Retinal fundus photograph, FOV: 45 degrees
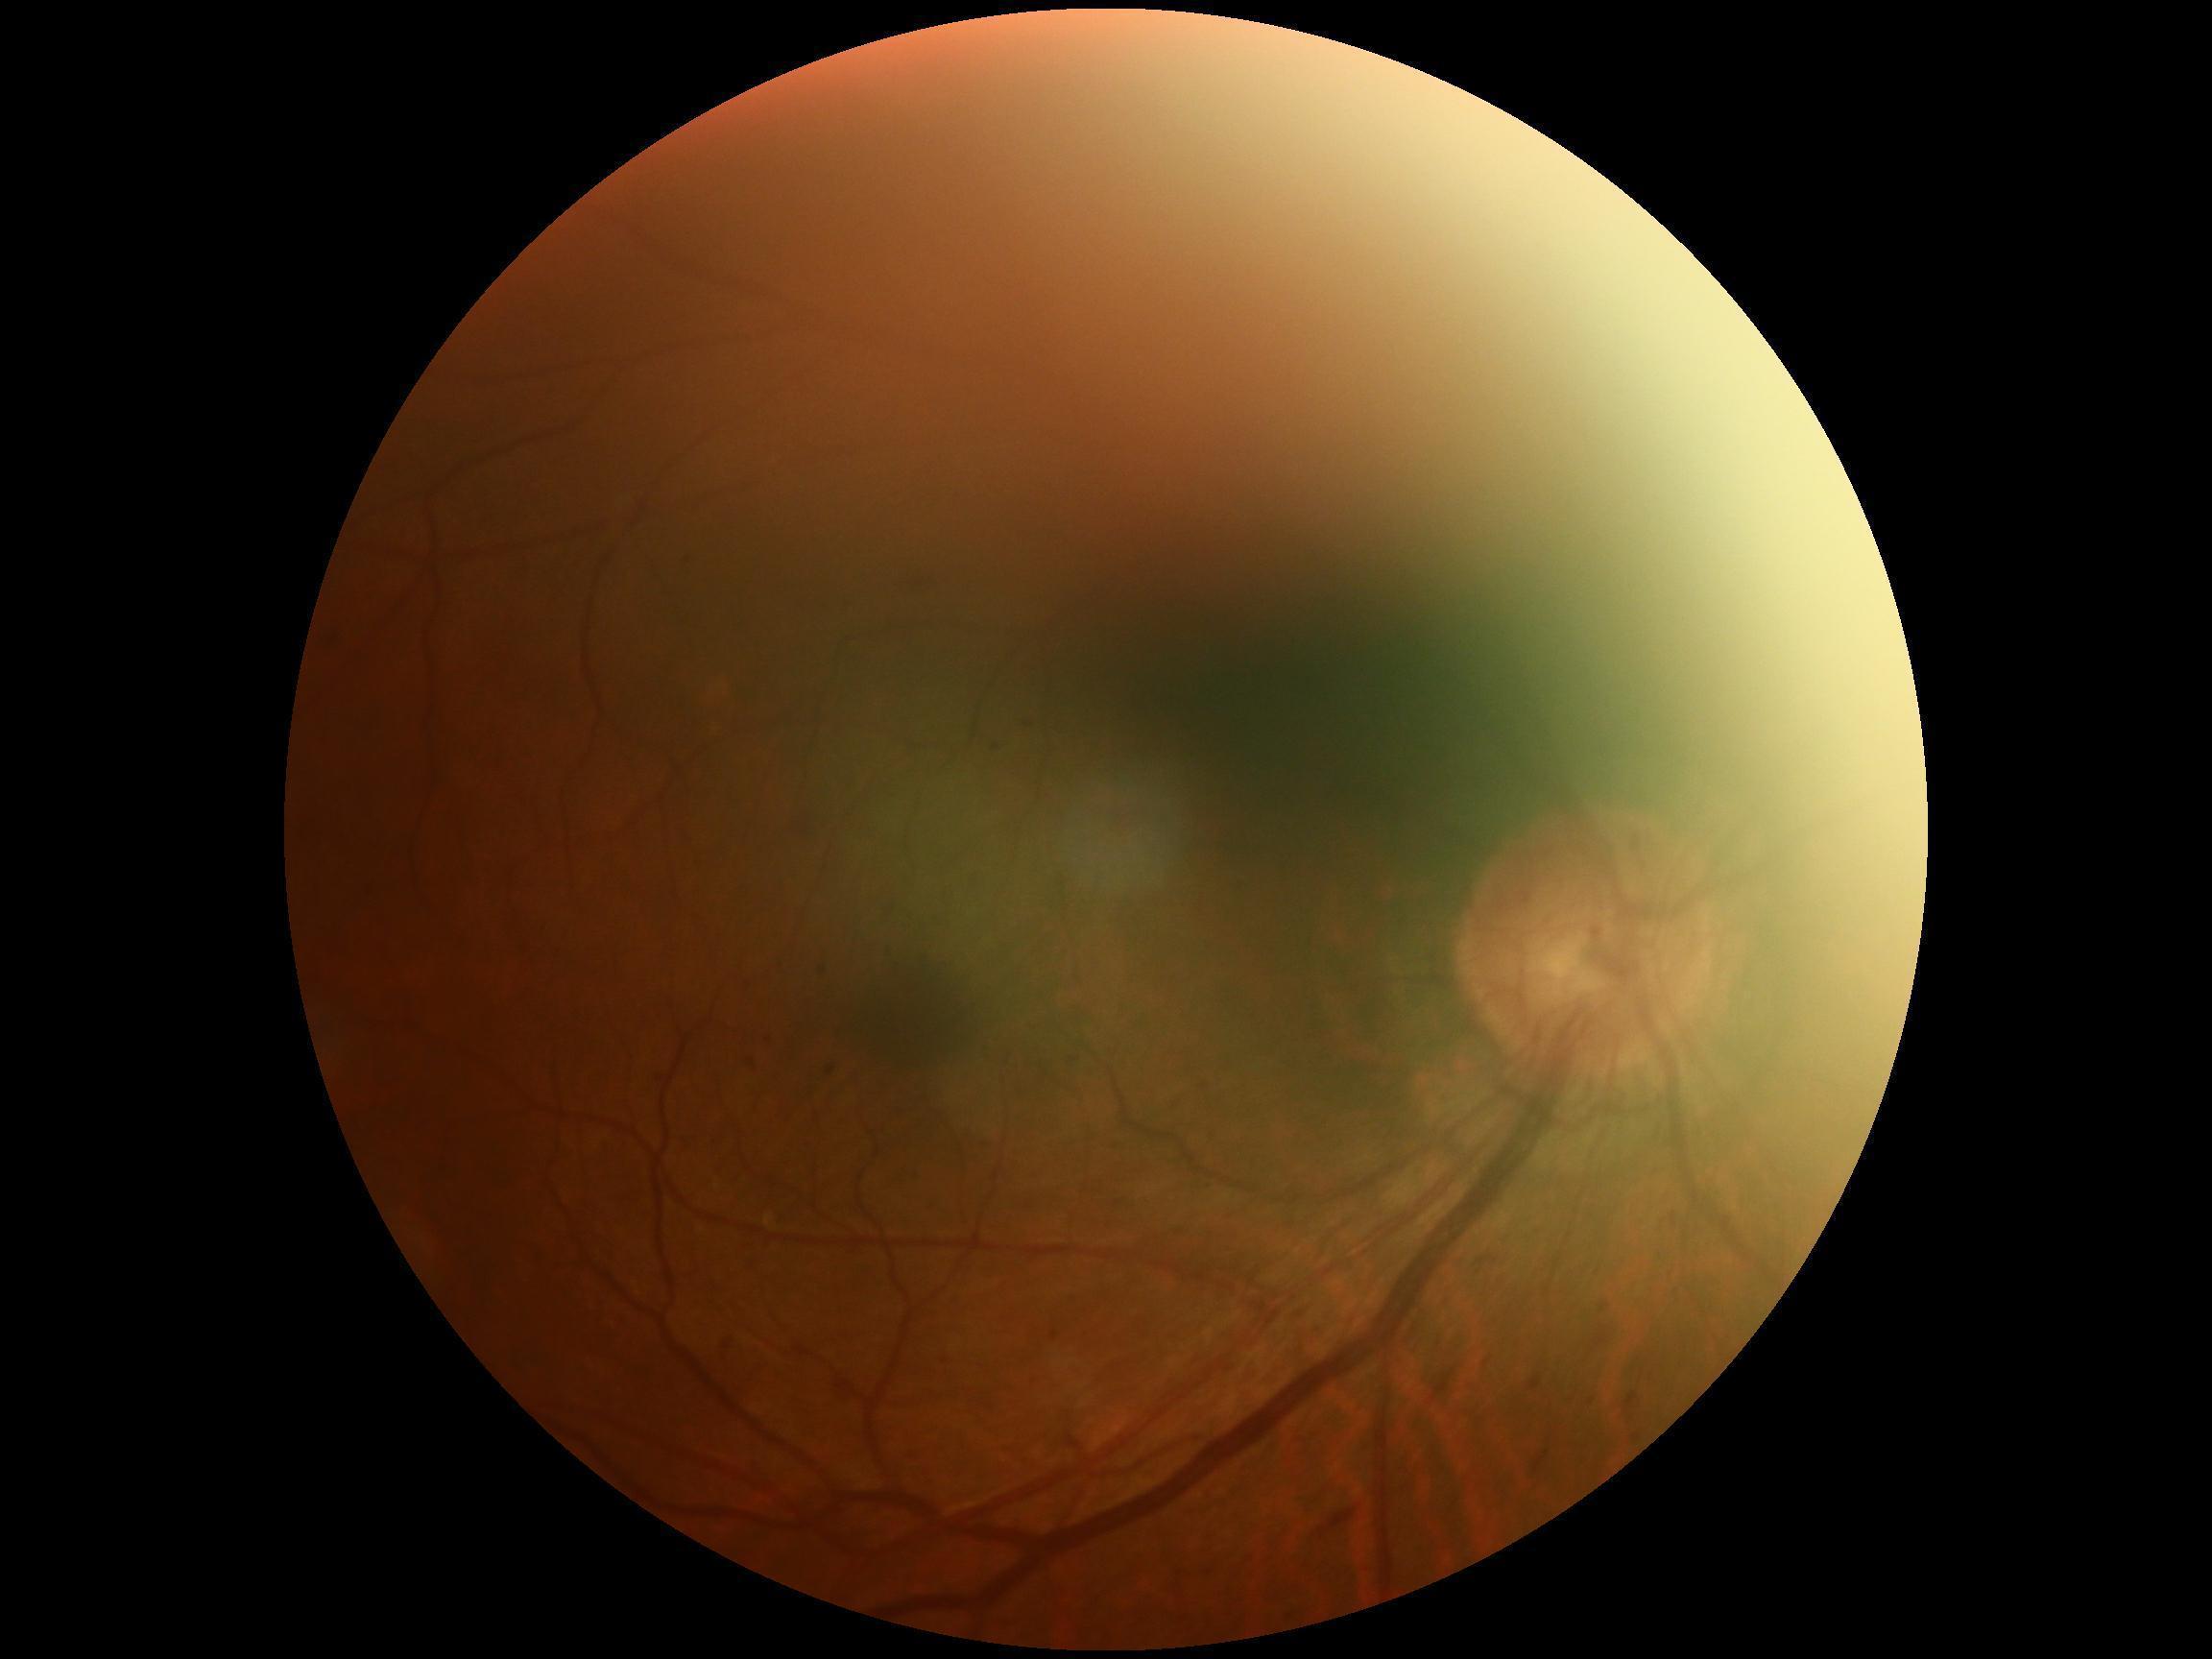 DR class@non-proliferative diabetic retinopathy, DR severity@2.